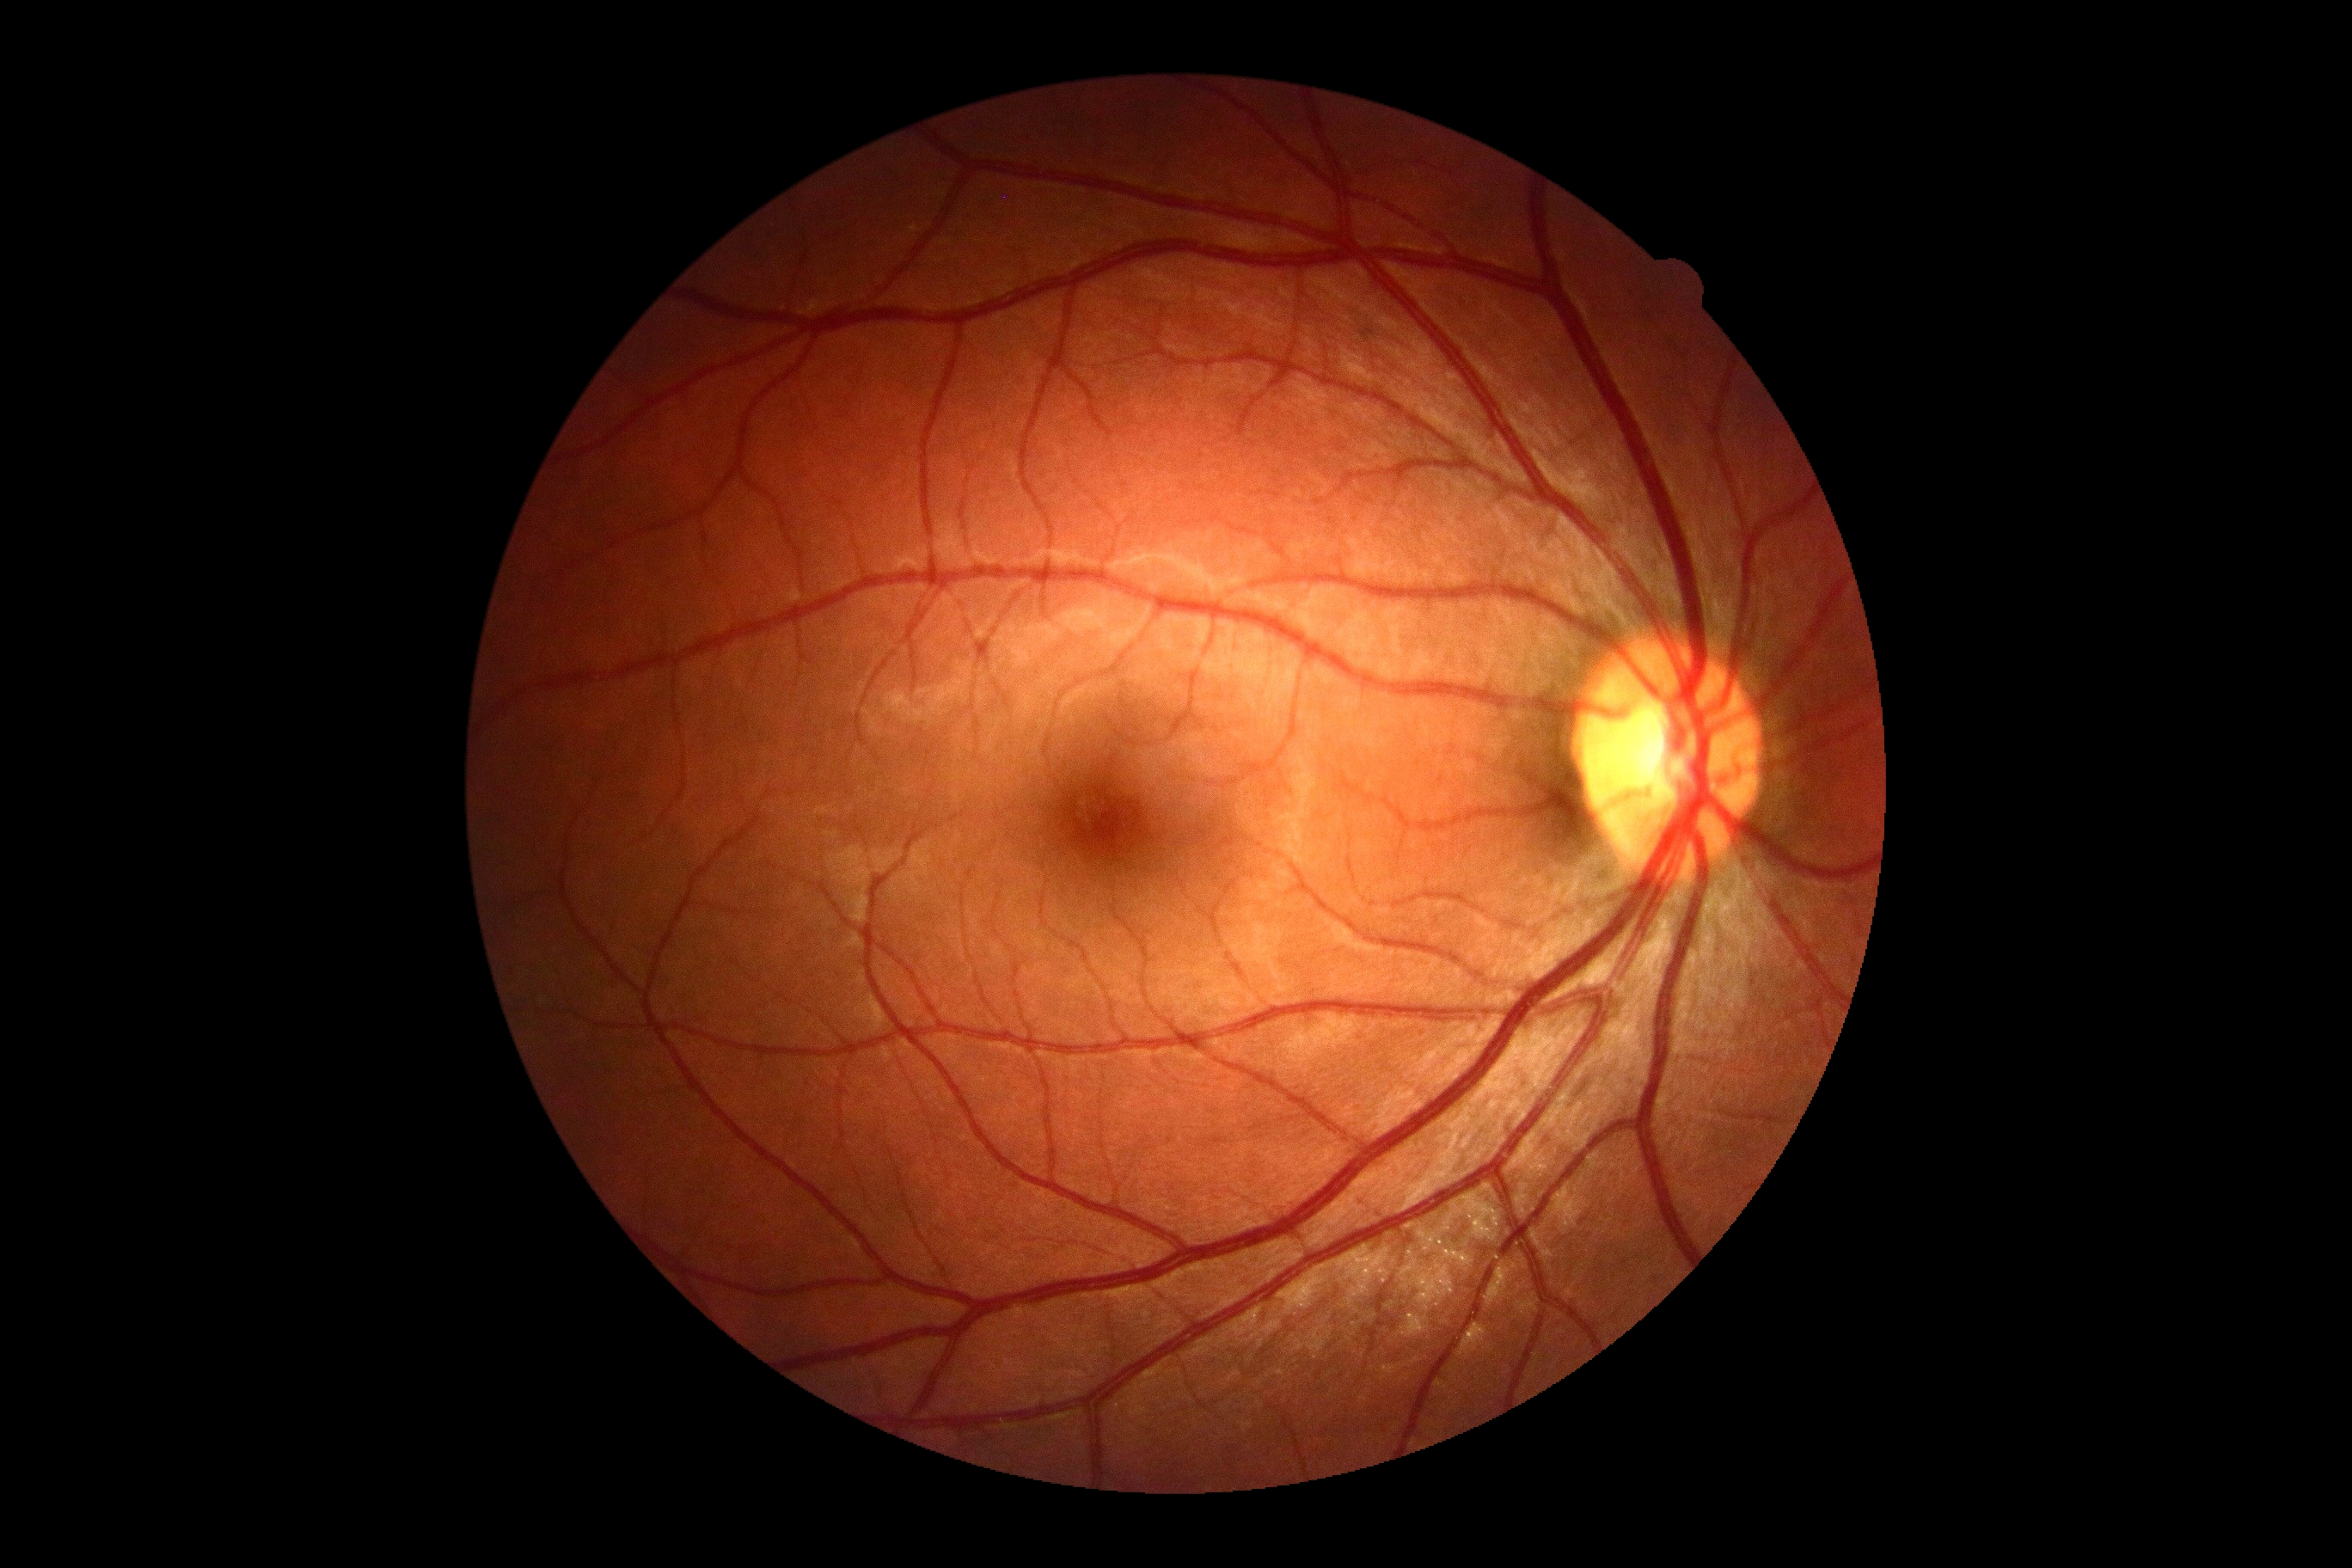 Diabetic retinopathy is 0. No apparent diabetic retinopathy.